Wide-field fundus image from infant ROP screening: 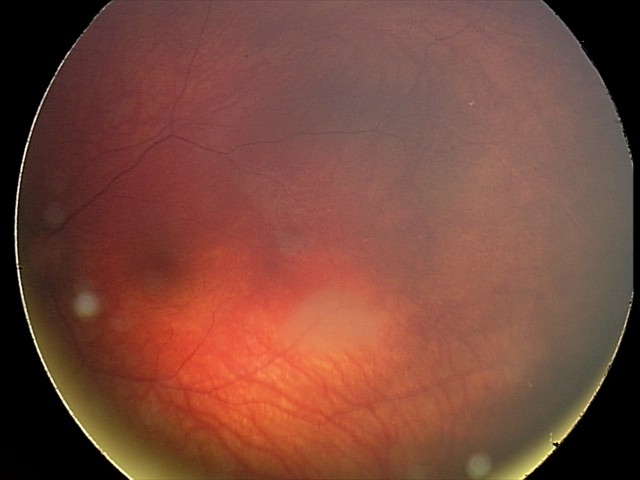
Screening series with retinal astrocytic hamartoma.